Graded on the modified Davis scale · 45-degree field of view · acquired with a NIDEK AFC-230 · nonmydriatic fundus photograph.
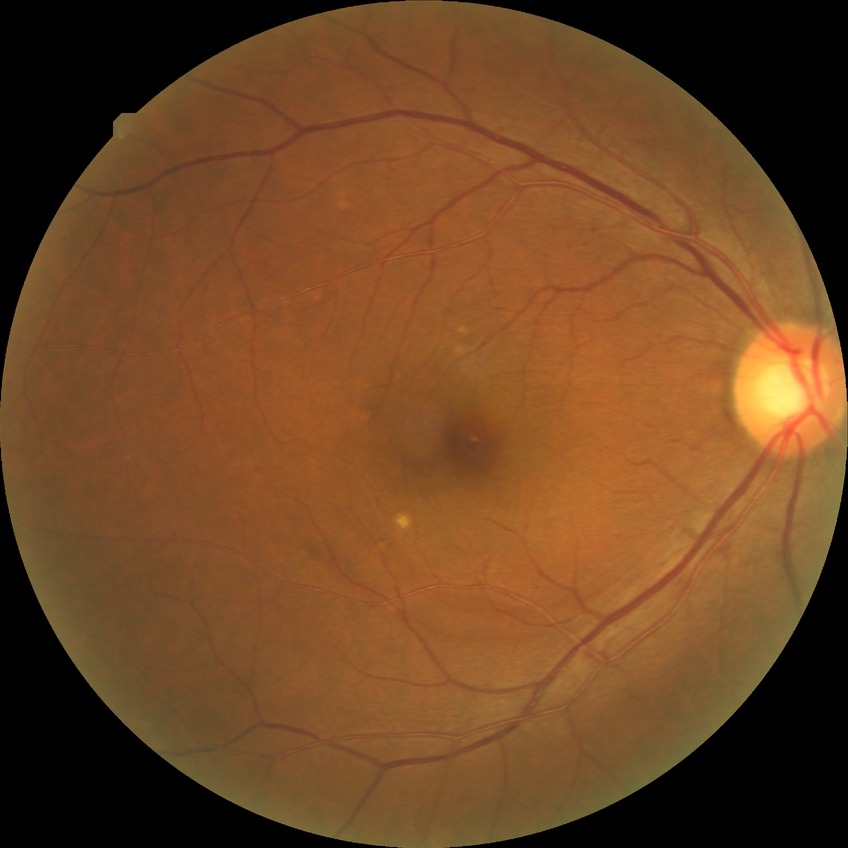
DR impression: no apparent DR; DR stage: NDR.